Captured on a Bosch fundus camera. CFP:
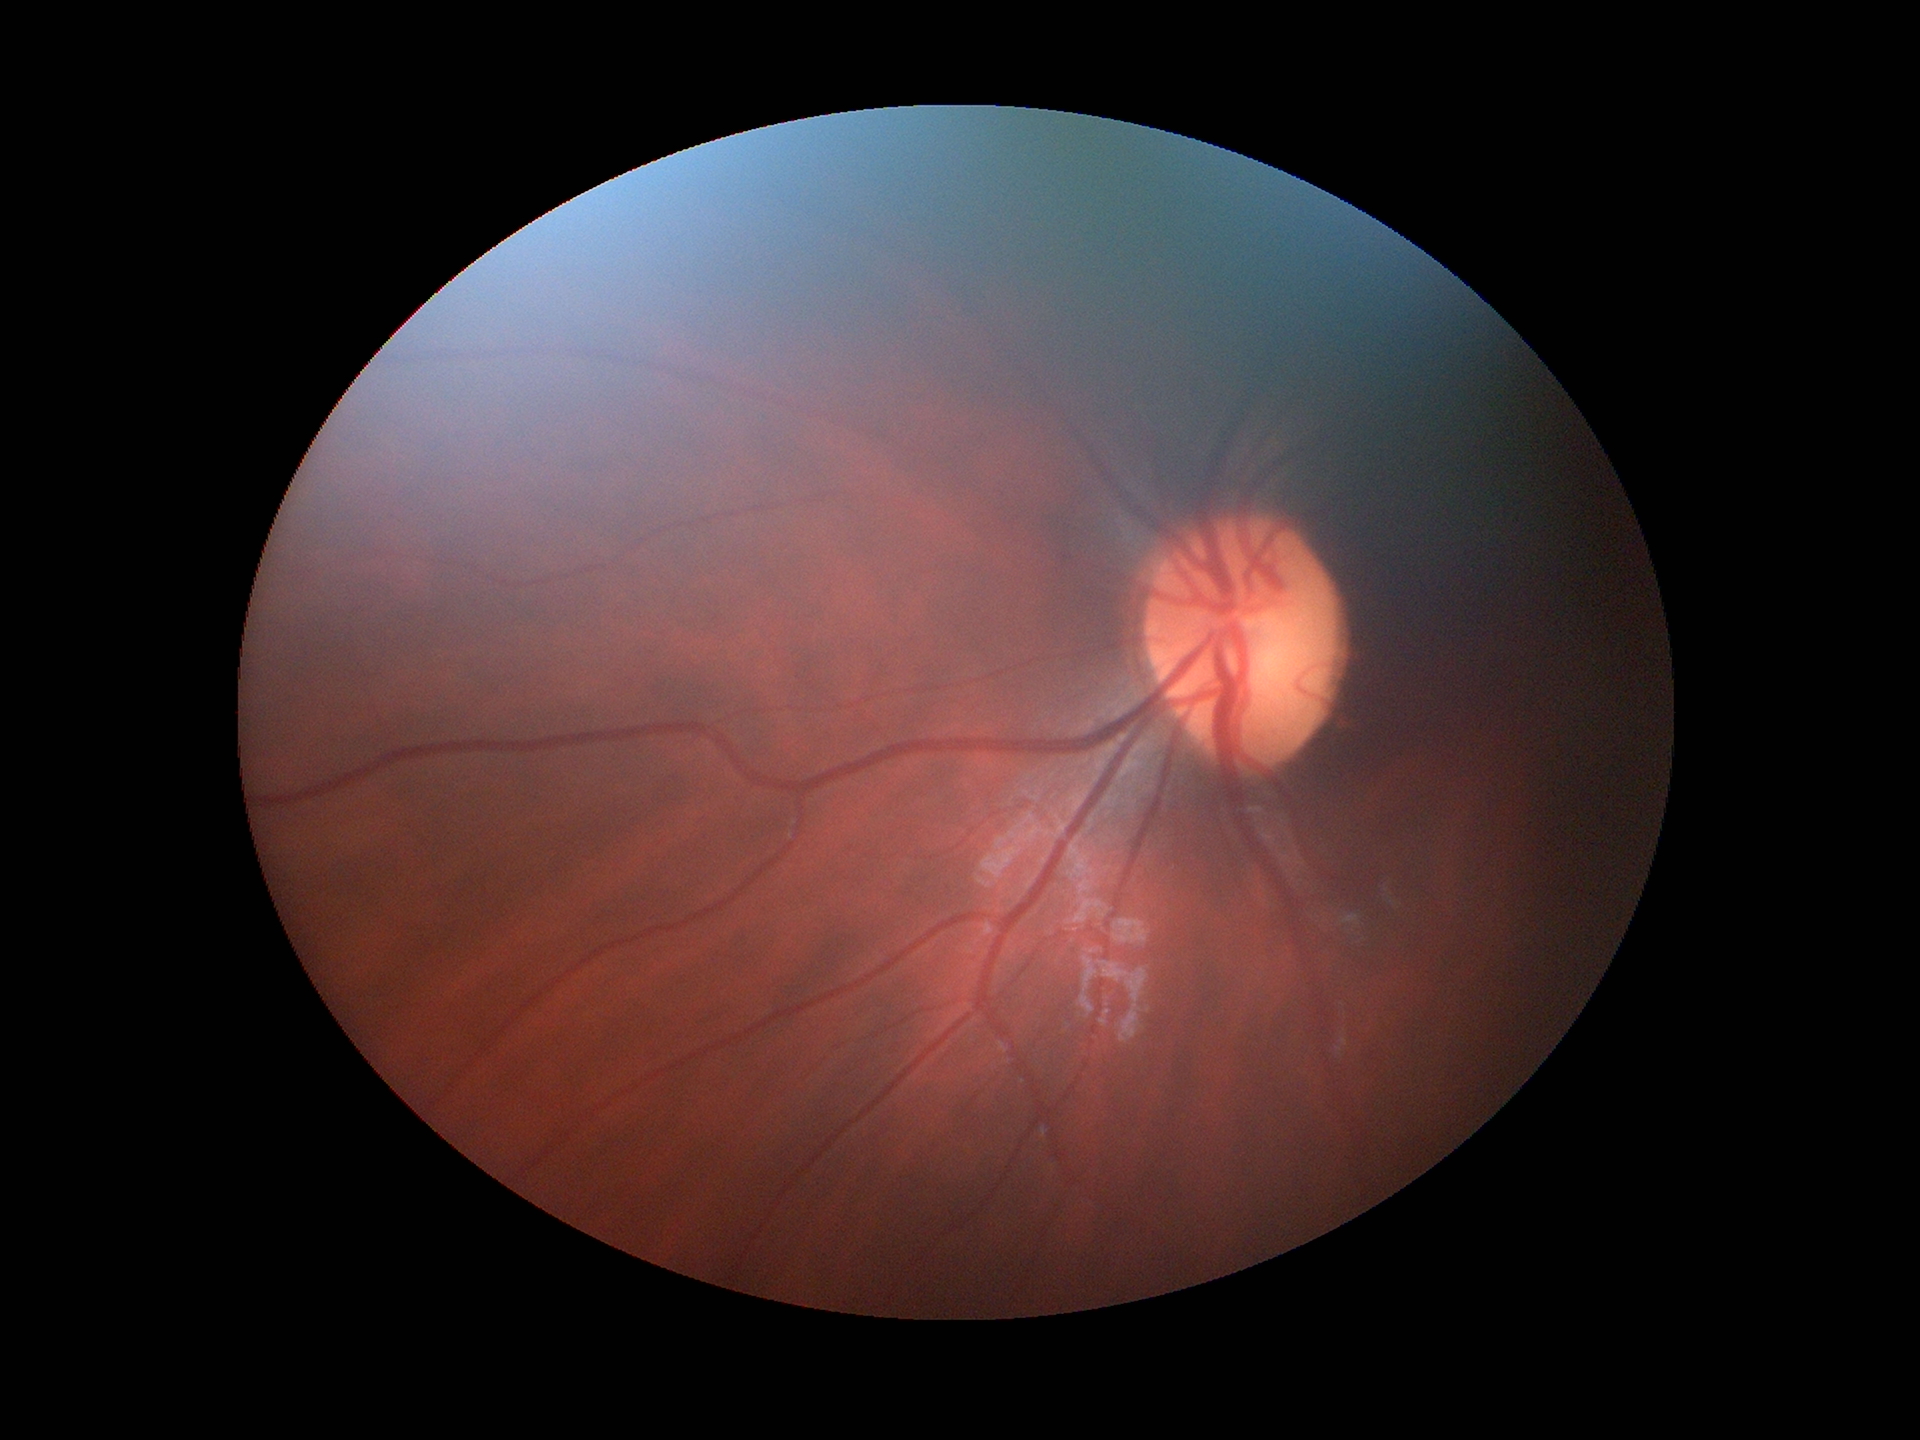 Q: Is there glaucoma suspicion?
A: no suspicious findings
Q: What is the ACDR?
A: 0.27
Q: What is the horizontal cup-to-disc ratio?
A: 0.52
Q: What is the vertical cup-to-disc ratio?
A: 0.52